Infant wide-field fundus photograph
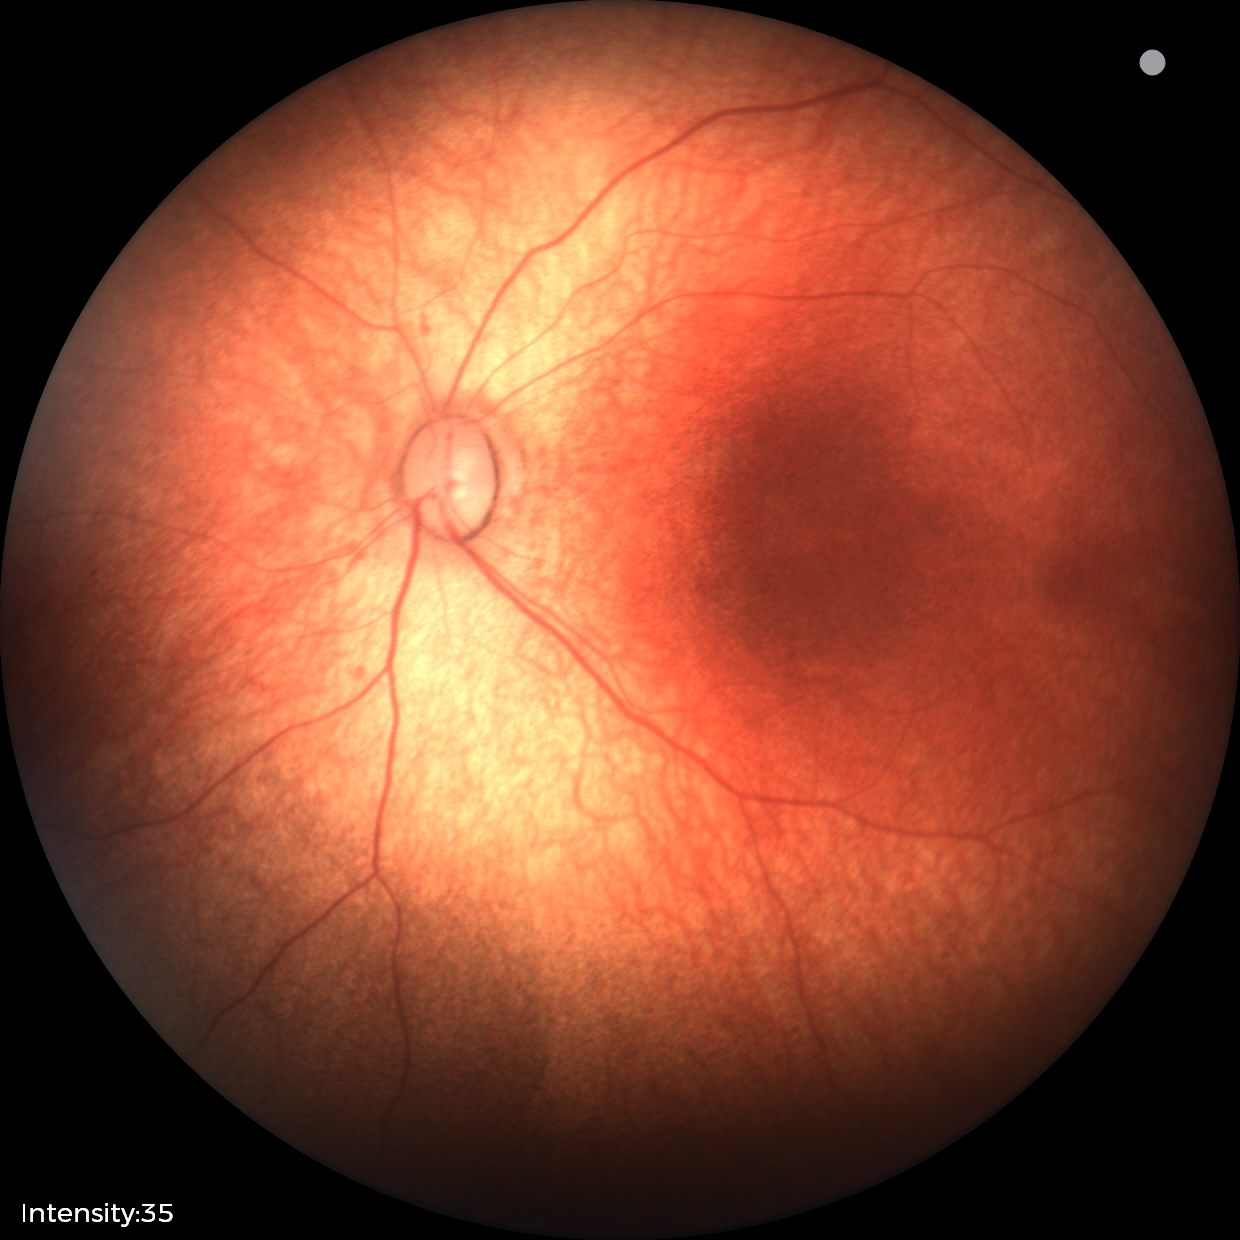
Normal screening examination.